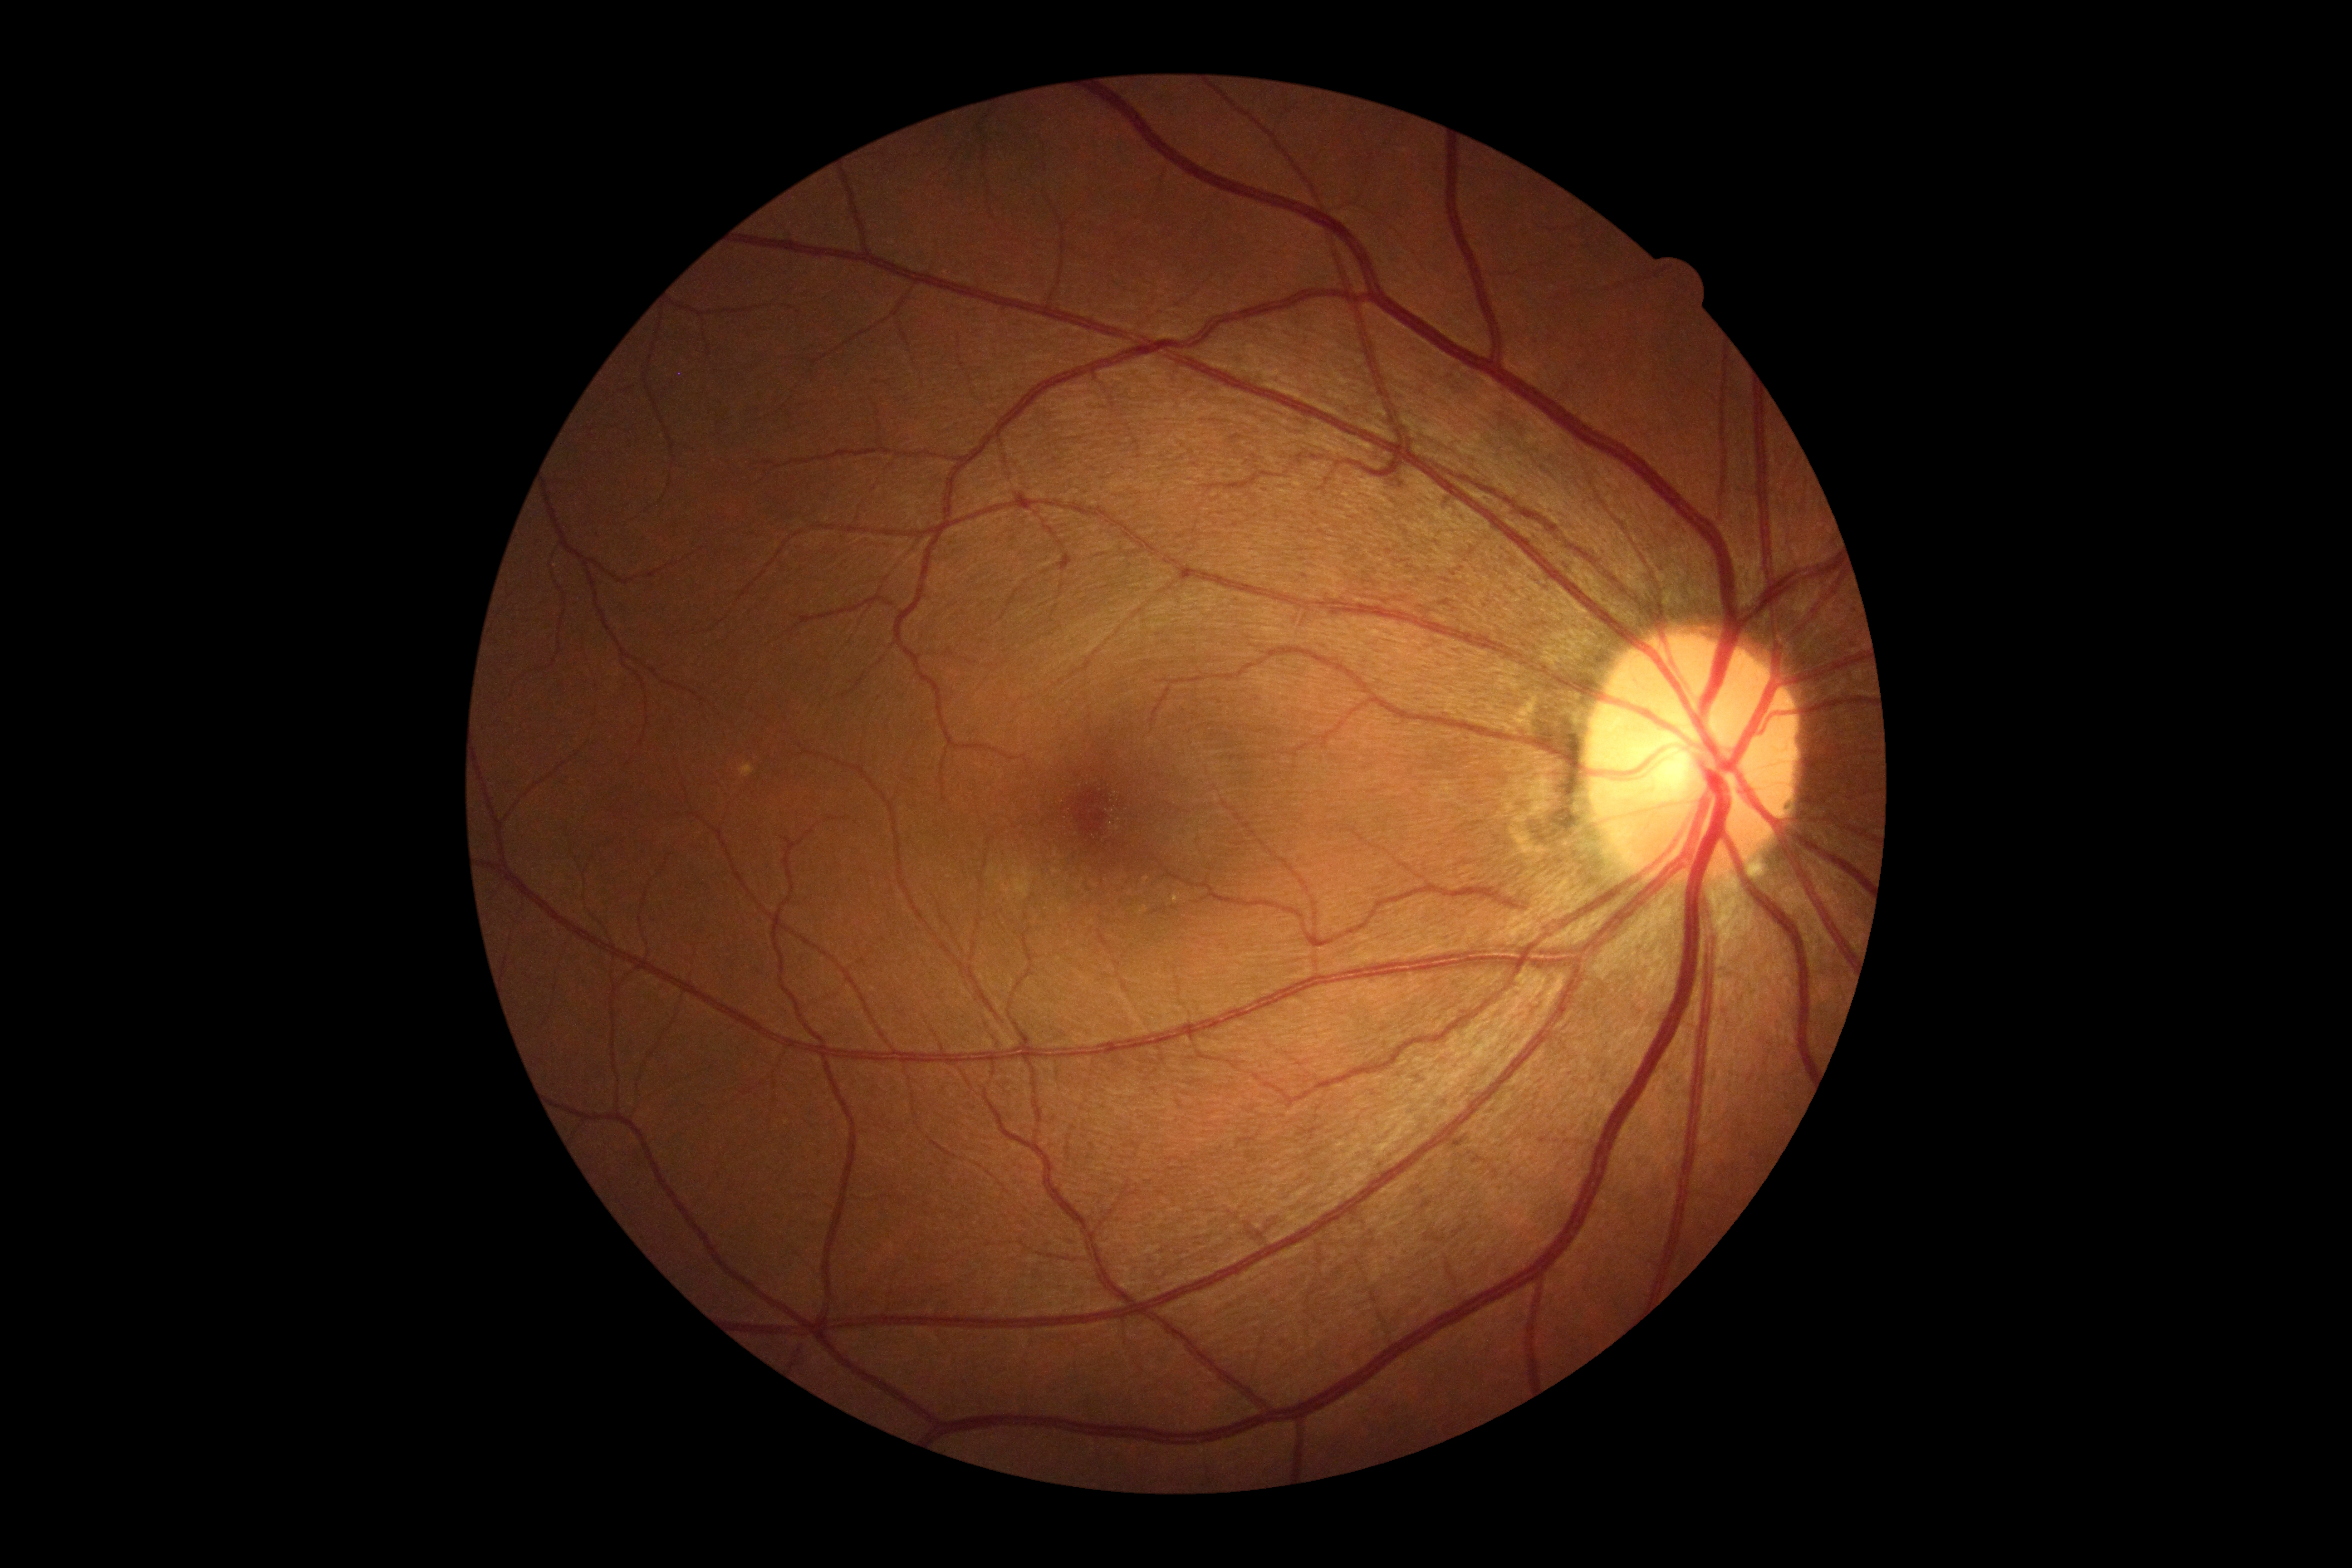 Retinopathy grade is 0 (no apparent retinopathy).